Camera: NIDEK AFC-230:
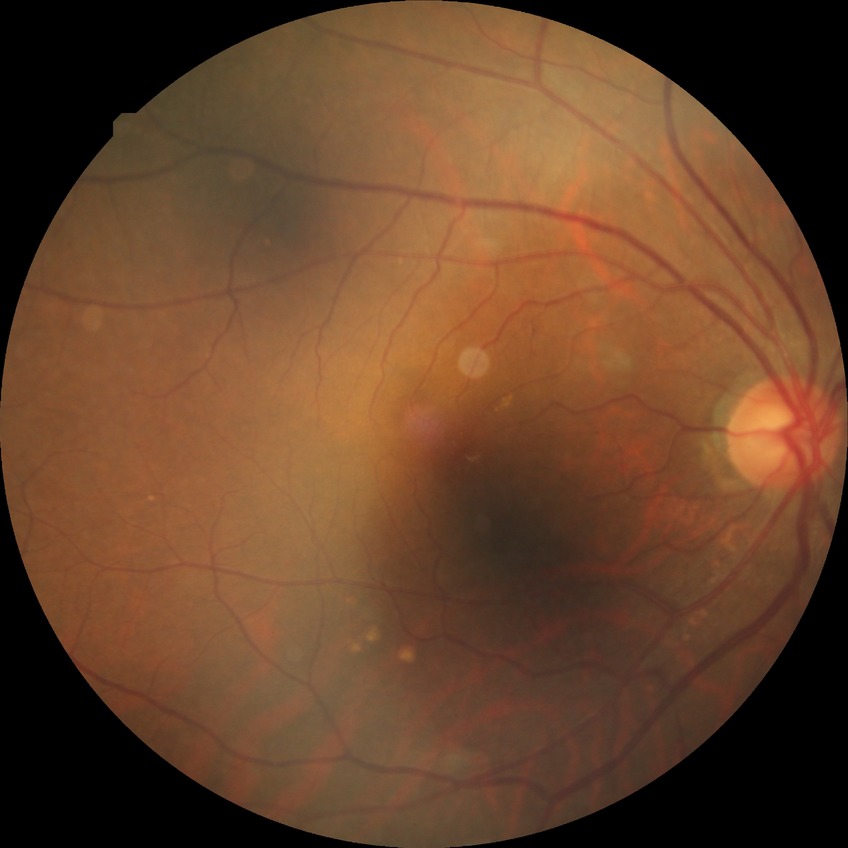 Davis grading=no diabetic retinopathy.